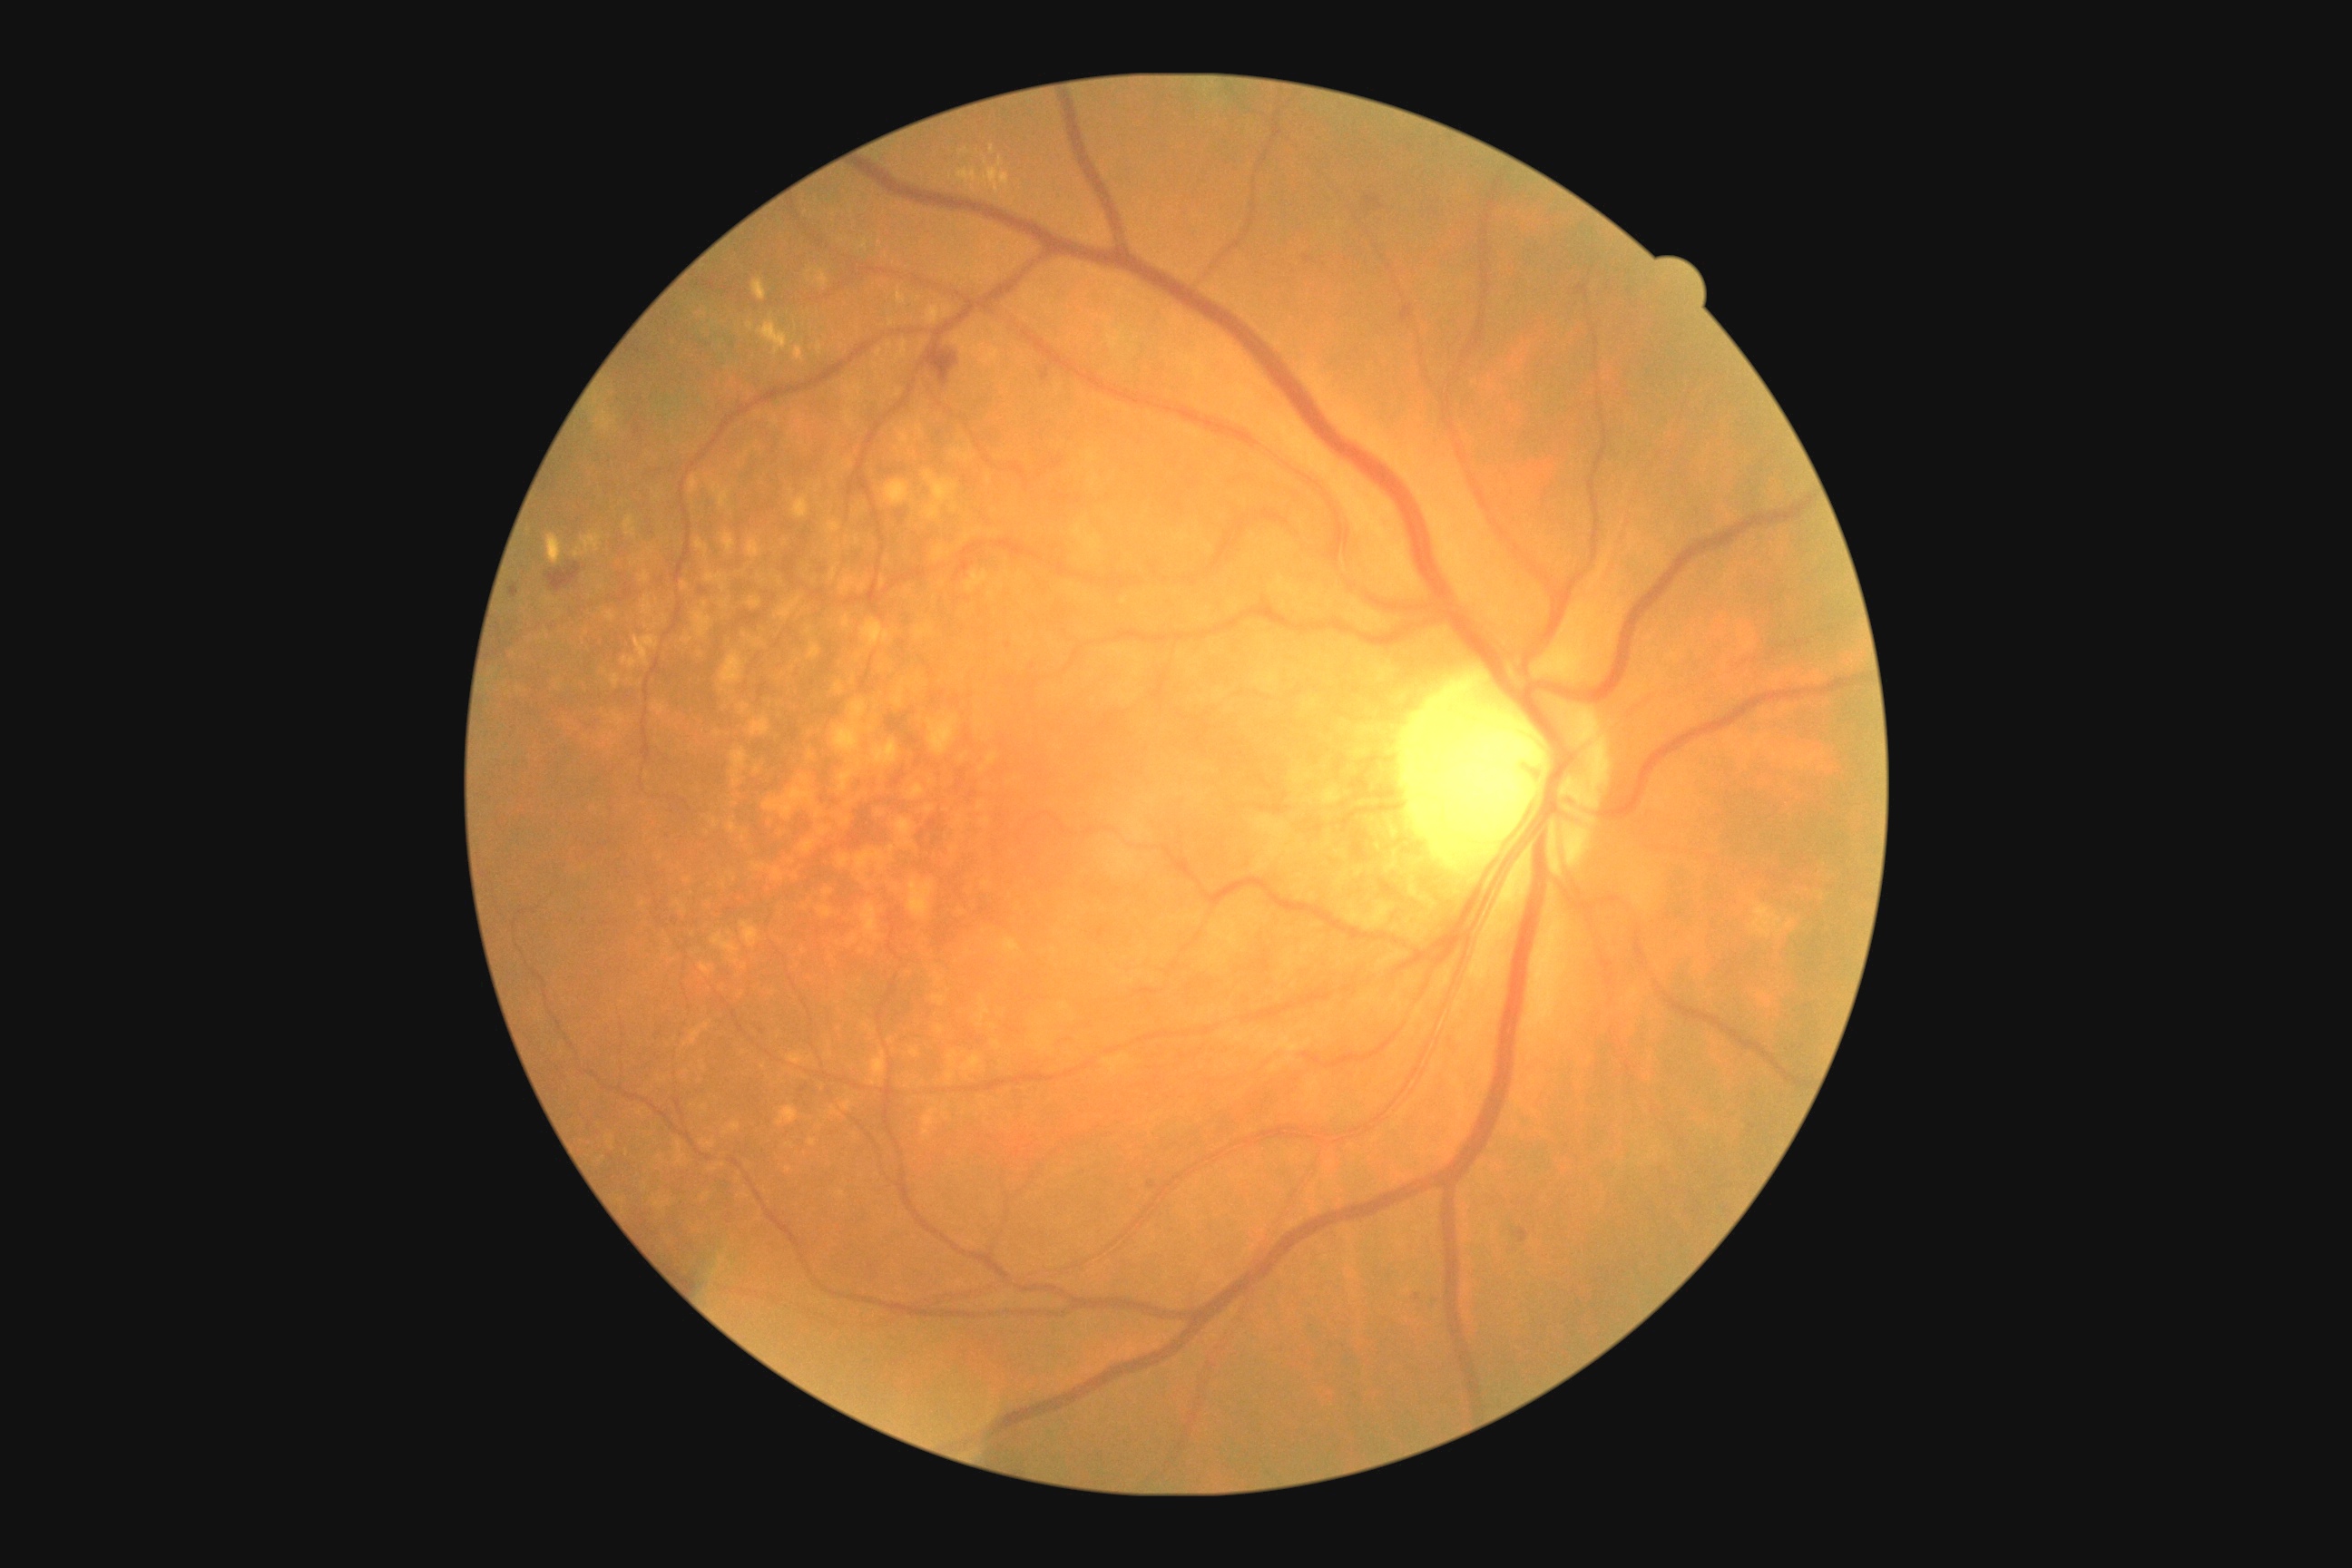
{"dr_grade": "grade 2"}